Captured with the Clarity RetCam 3 (130° field of view). 640x480. Infant wide-field fundus photograph: 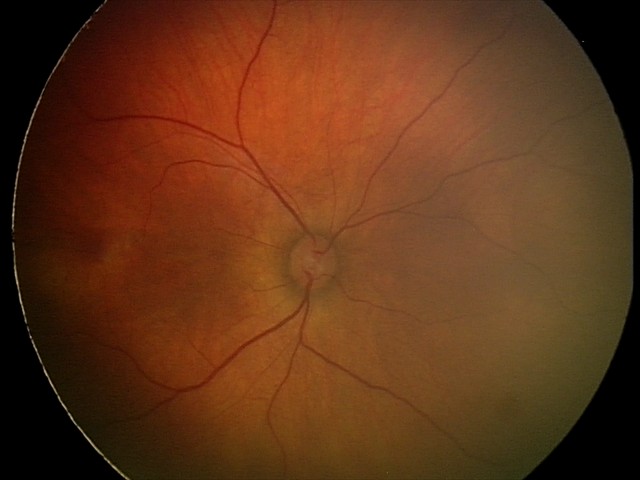
Screening: retinal hemorrhages.